Camera: Clarity RetCam 3 (130° FOV); 640 by 480 pixels; infant wide-field fundus photograph: 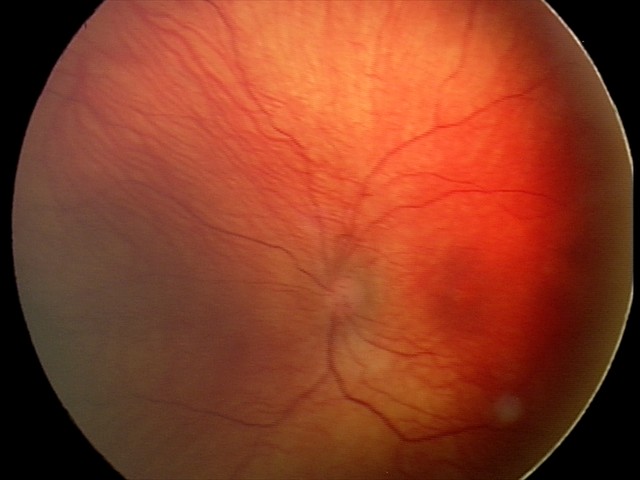
Diagnosis from this screening exam: status post retinopathy of prematurity (ROP). No plus disease.